Wide-field fundus photograph from neonatal ROP screening.
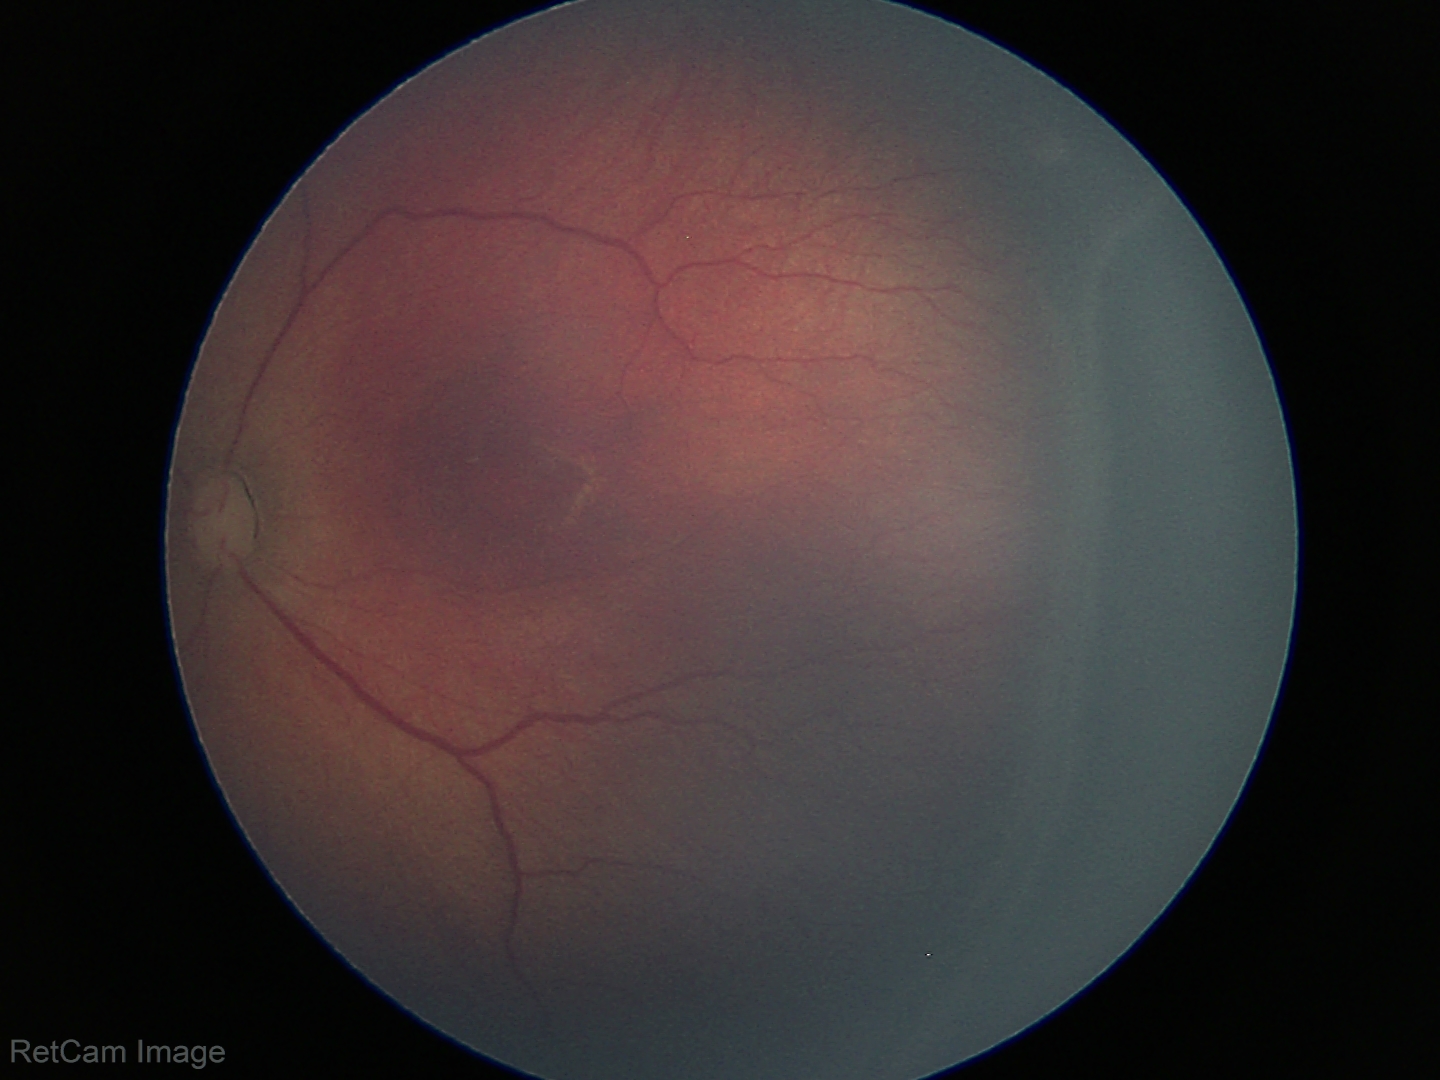 Screening: no plus disease | retinopathy of prematurity (ROP) stage 3 — ridge with extraretinal fibrovascular proliferation.